Color fundus photograph.
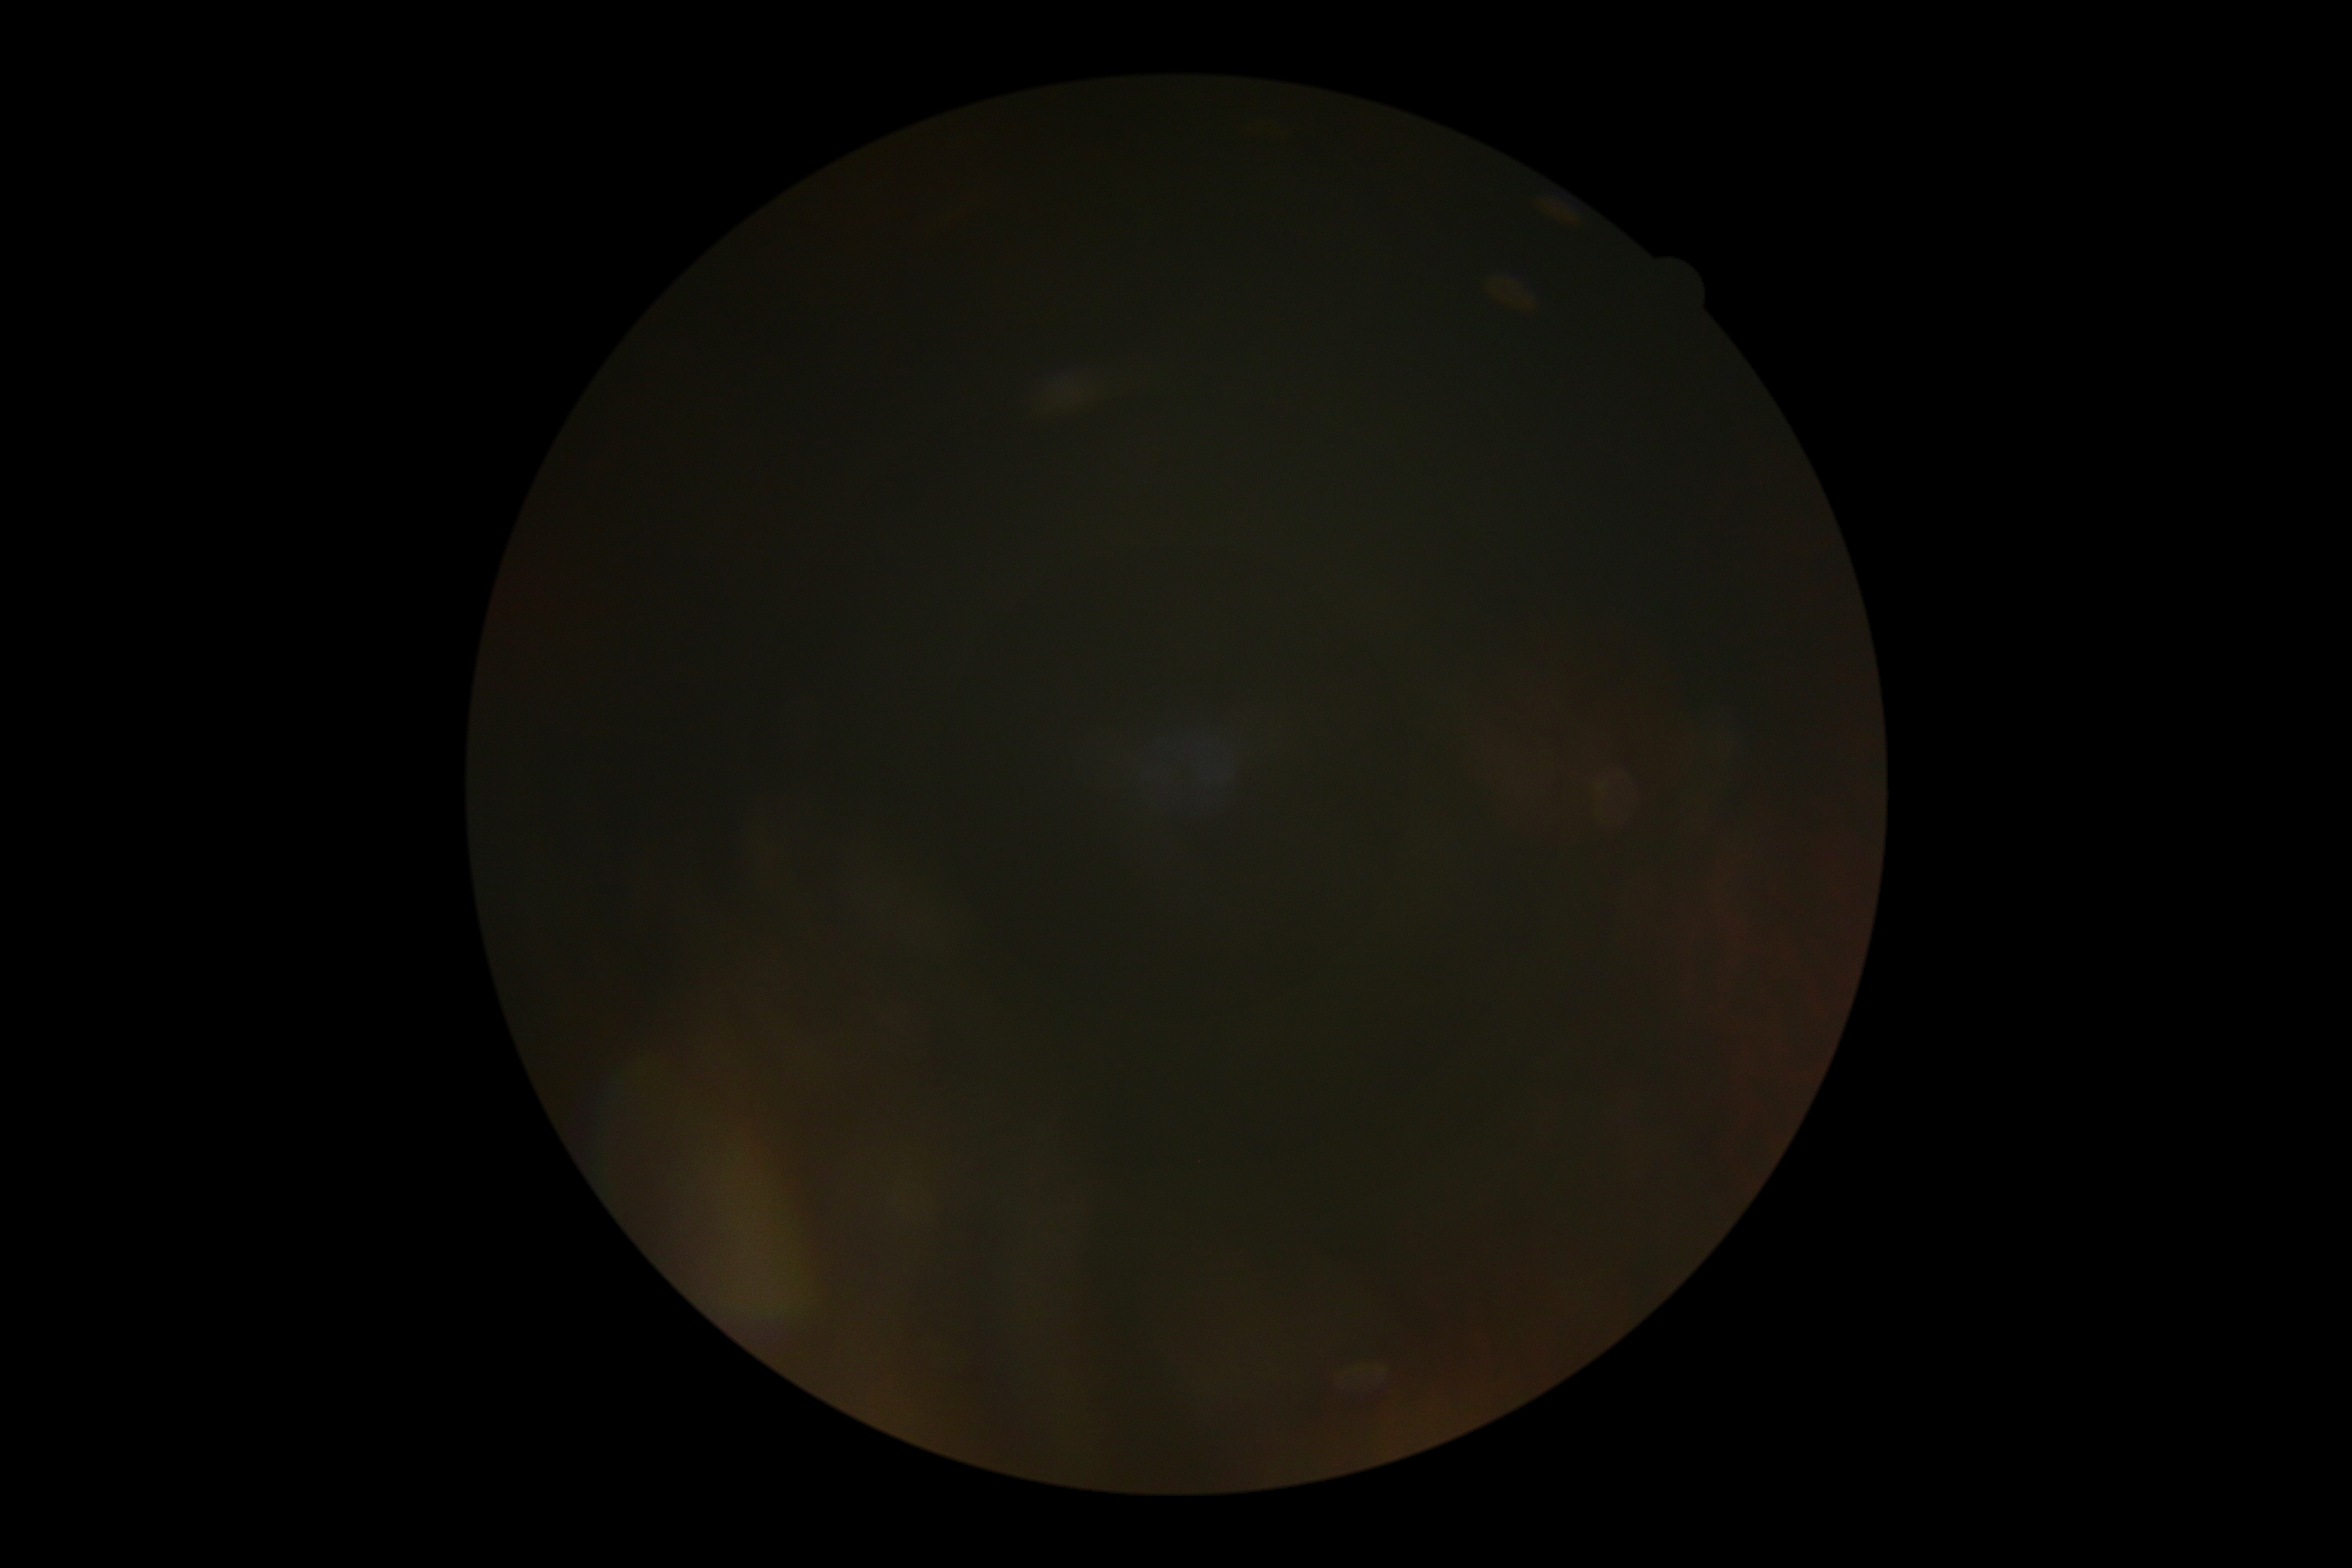 DR grade=ungradable.